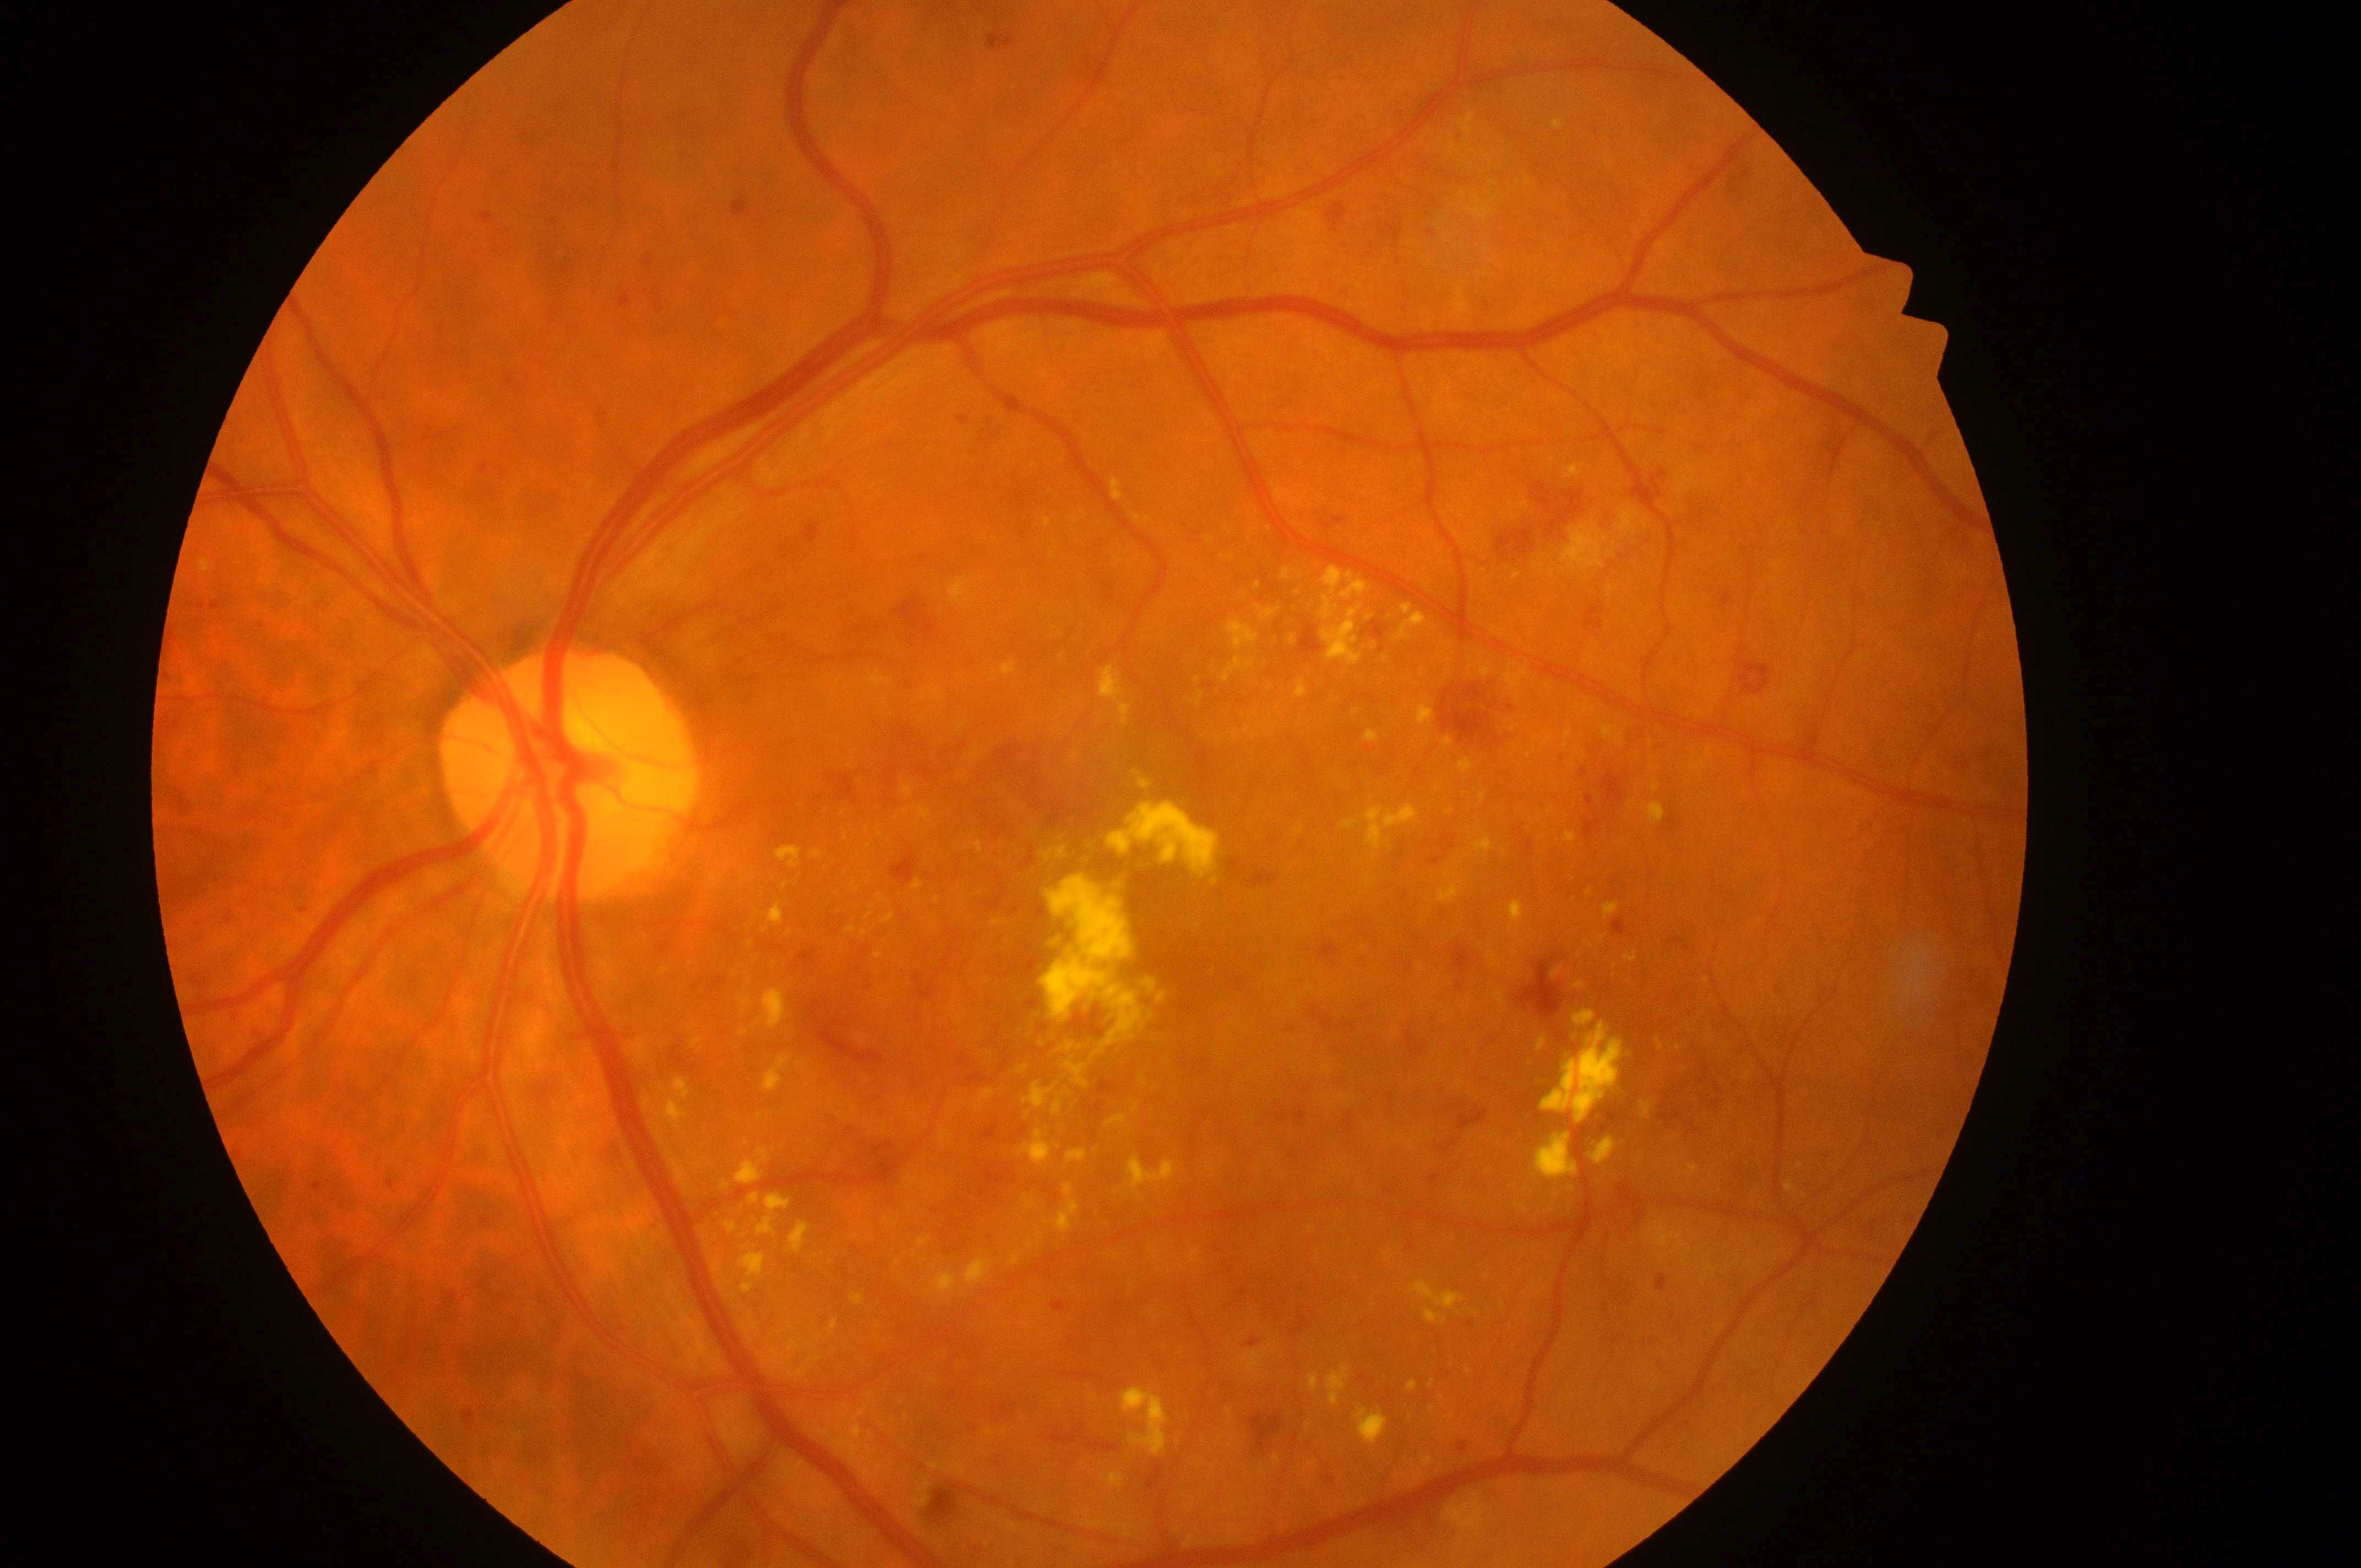
Fovea: 1107, 919.
Diabetic retinopathy (DR): grade 3 (severe NPDR).
The image shows the left eye.
Disc center located at 561, 779.
Diabetic macular edema (DME) is grade 2 (high risk).